2352x1568px · 45° FOV · CFP
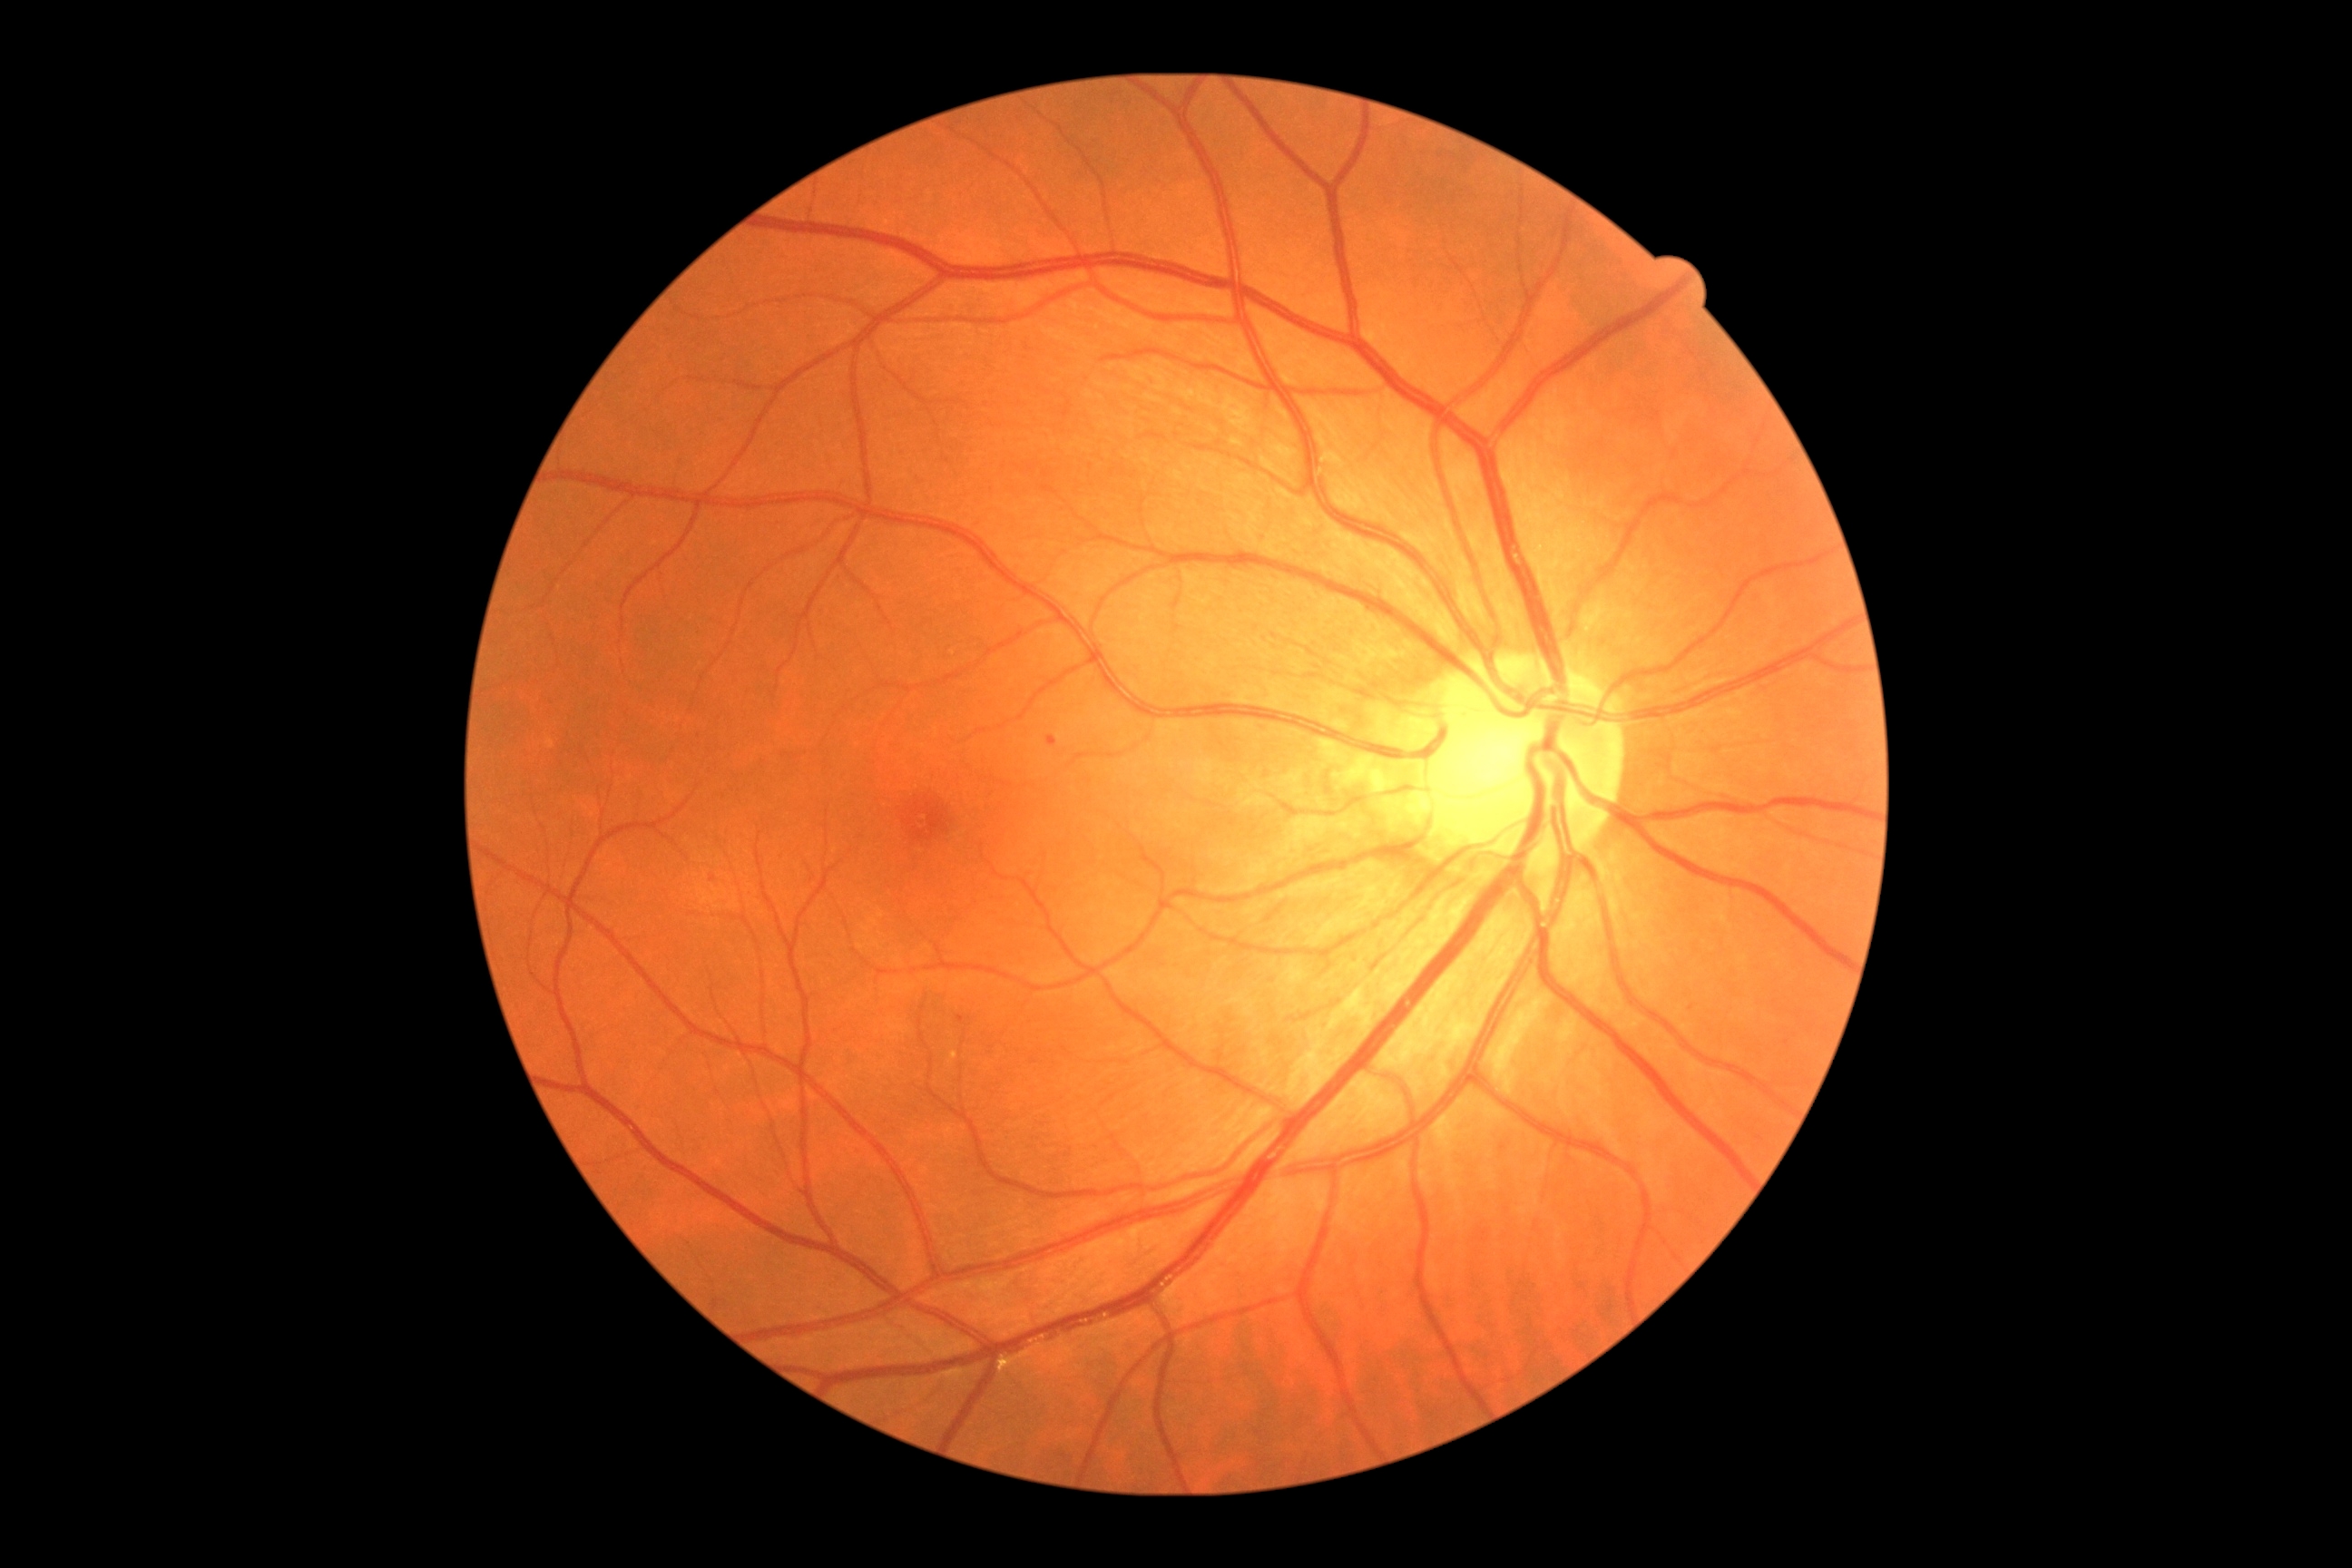
Diabetic retinopathy (DR) is mild non-proliferative diabetic retinopathy (grade 1); non-proliferative diabetic retinopathy
Representative lesions:
hemorrhages (HEs): not present
microaneurysms (MAs) (partial): BBox(957, 1015, 965, 1023)
Additional small MAs near (1053; 743), (713; 880)
hard exudates (EXs): not present
soft exudates (SEs): not present